1440x1080px · infant wide-field fundus photograph:
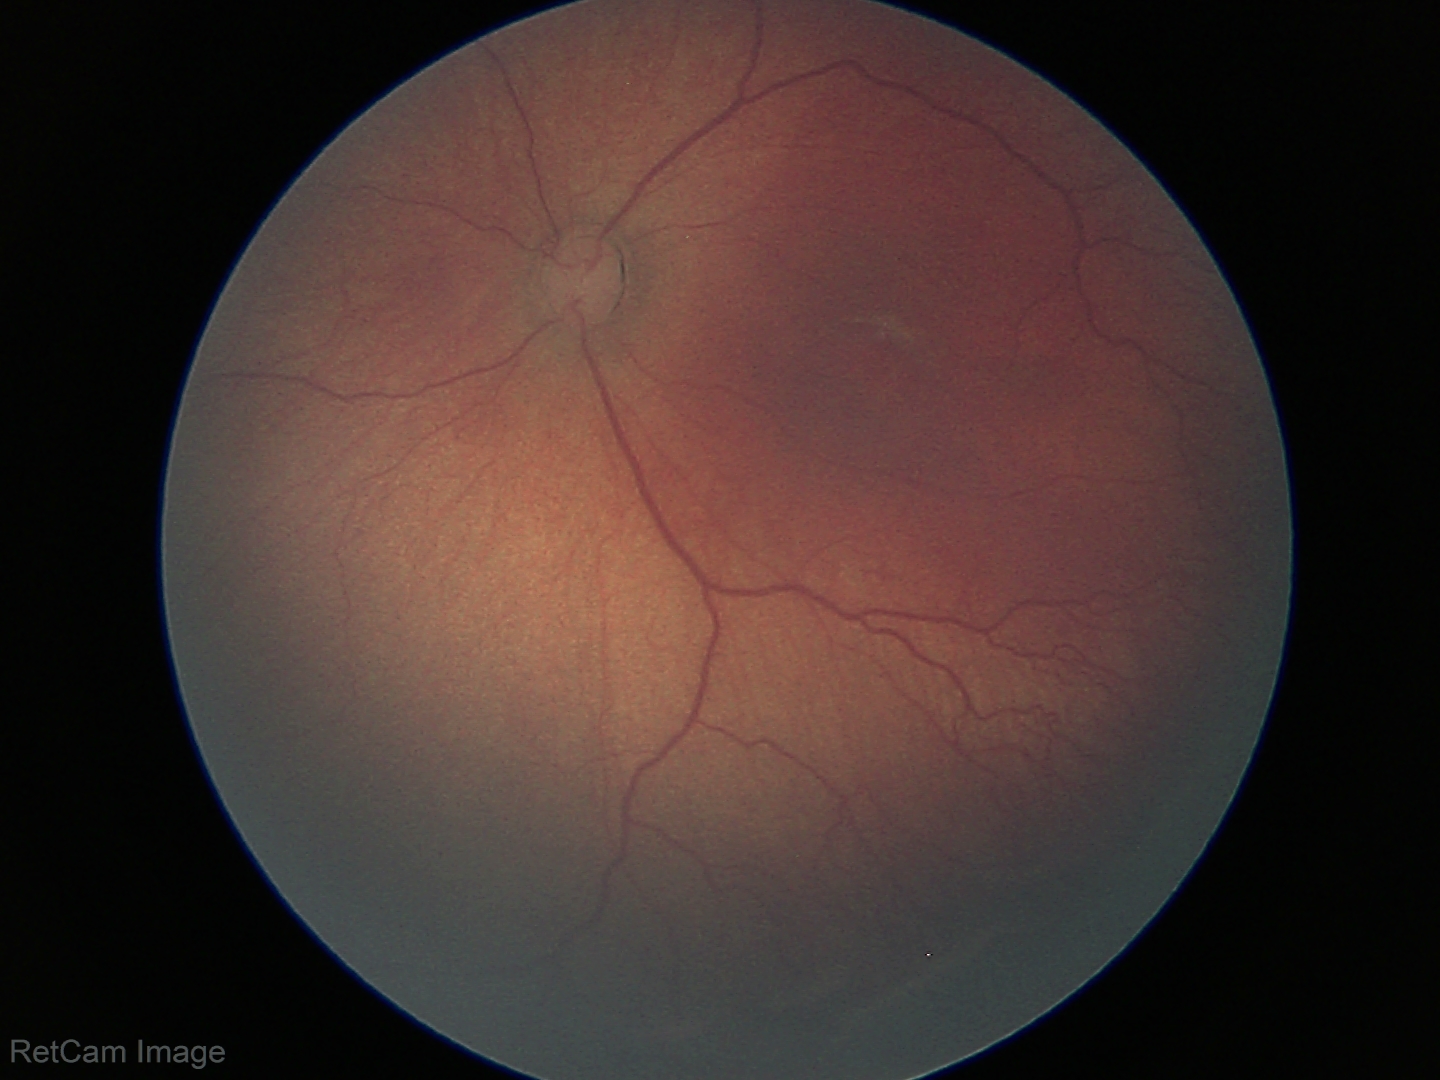 Plus form = absent — posterior pole vessels without abnormal dilation or tortuosity, assessment = retinopathy of prematurity stage 2.